Acquired with a NIDEK AFC-230; 848x848px; graded on the modified Davis scale — 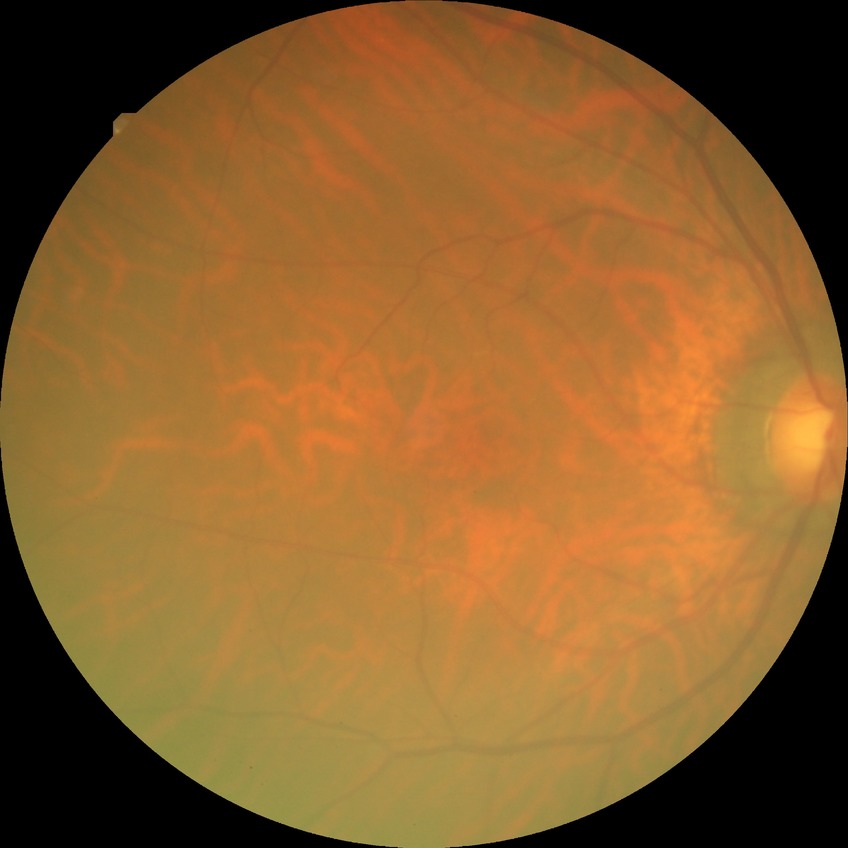 diabetic retinopathy (DR): no diabetic retinopathy (NDR).